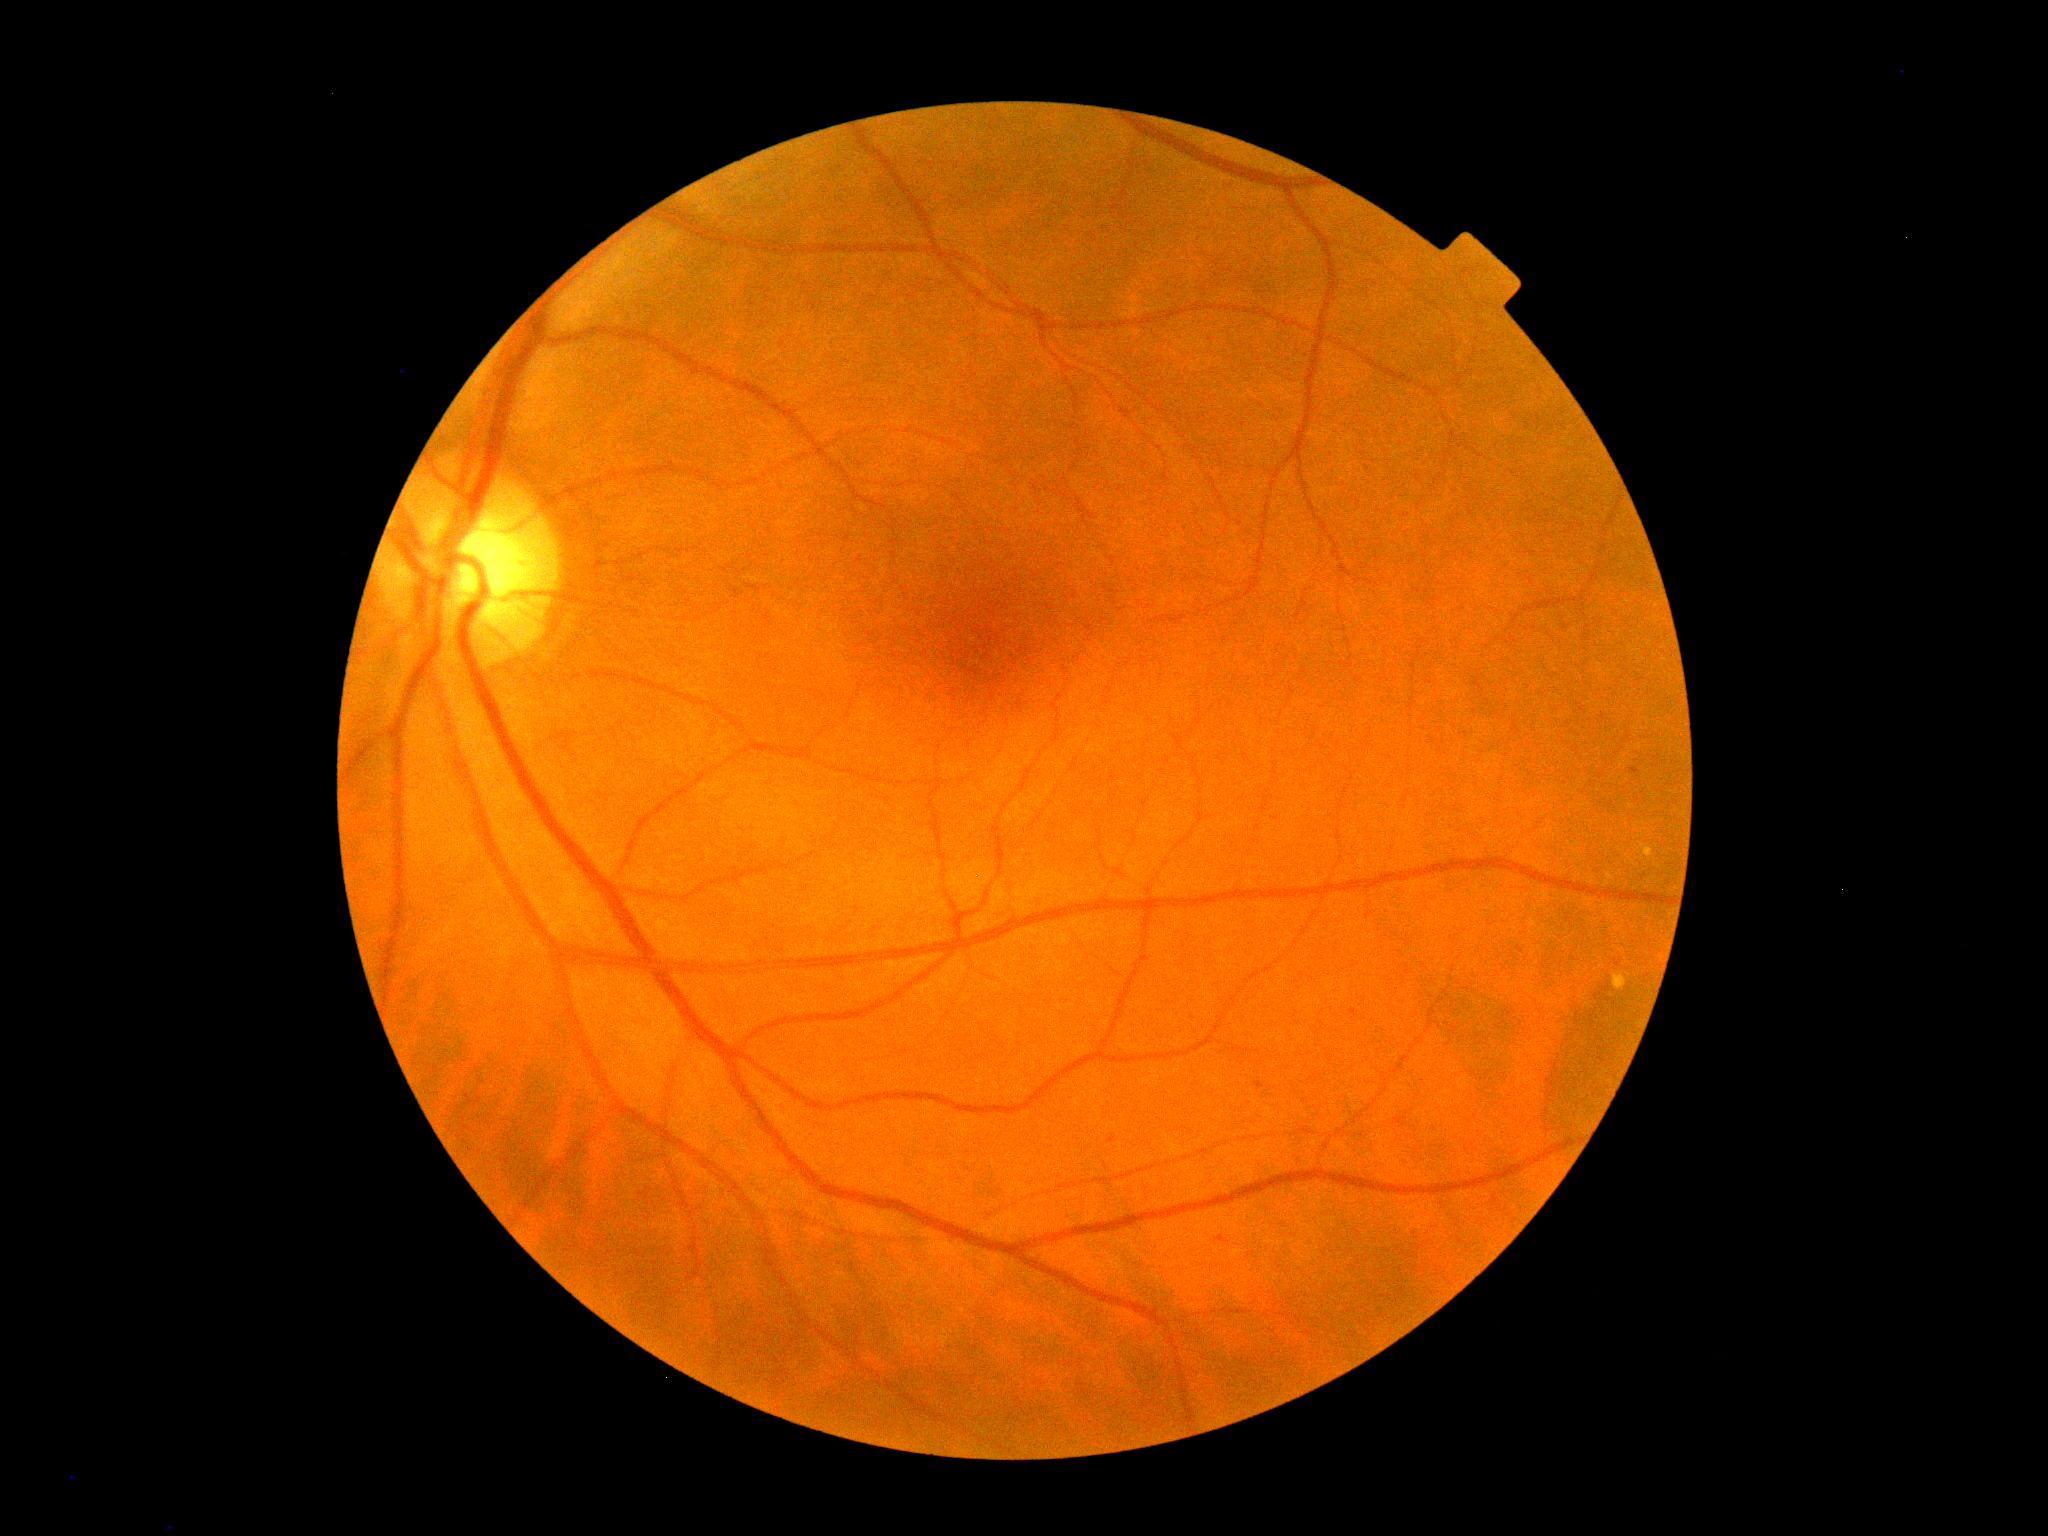 DR grade is 1.